1932 by 1932 pixels — 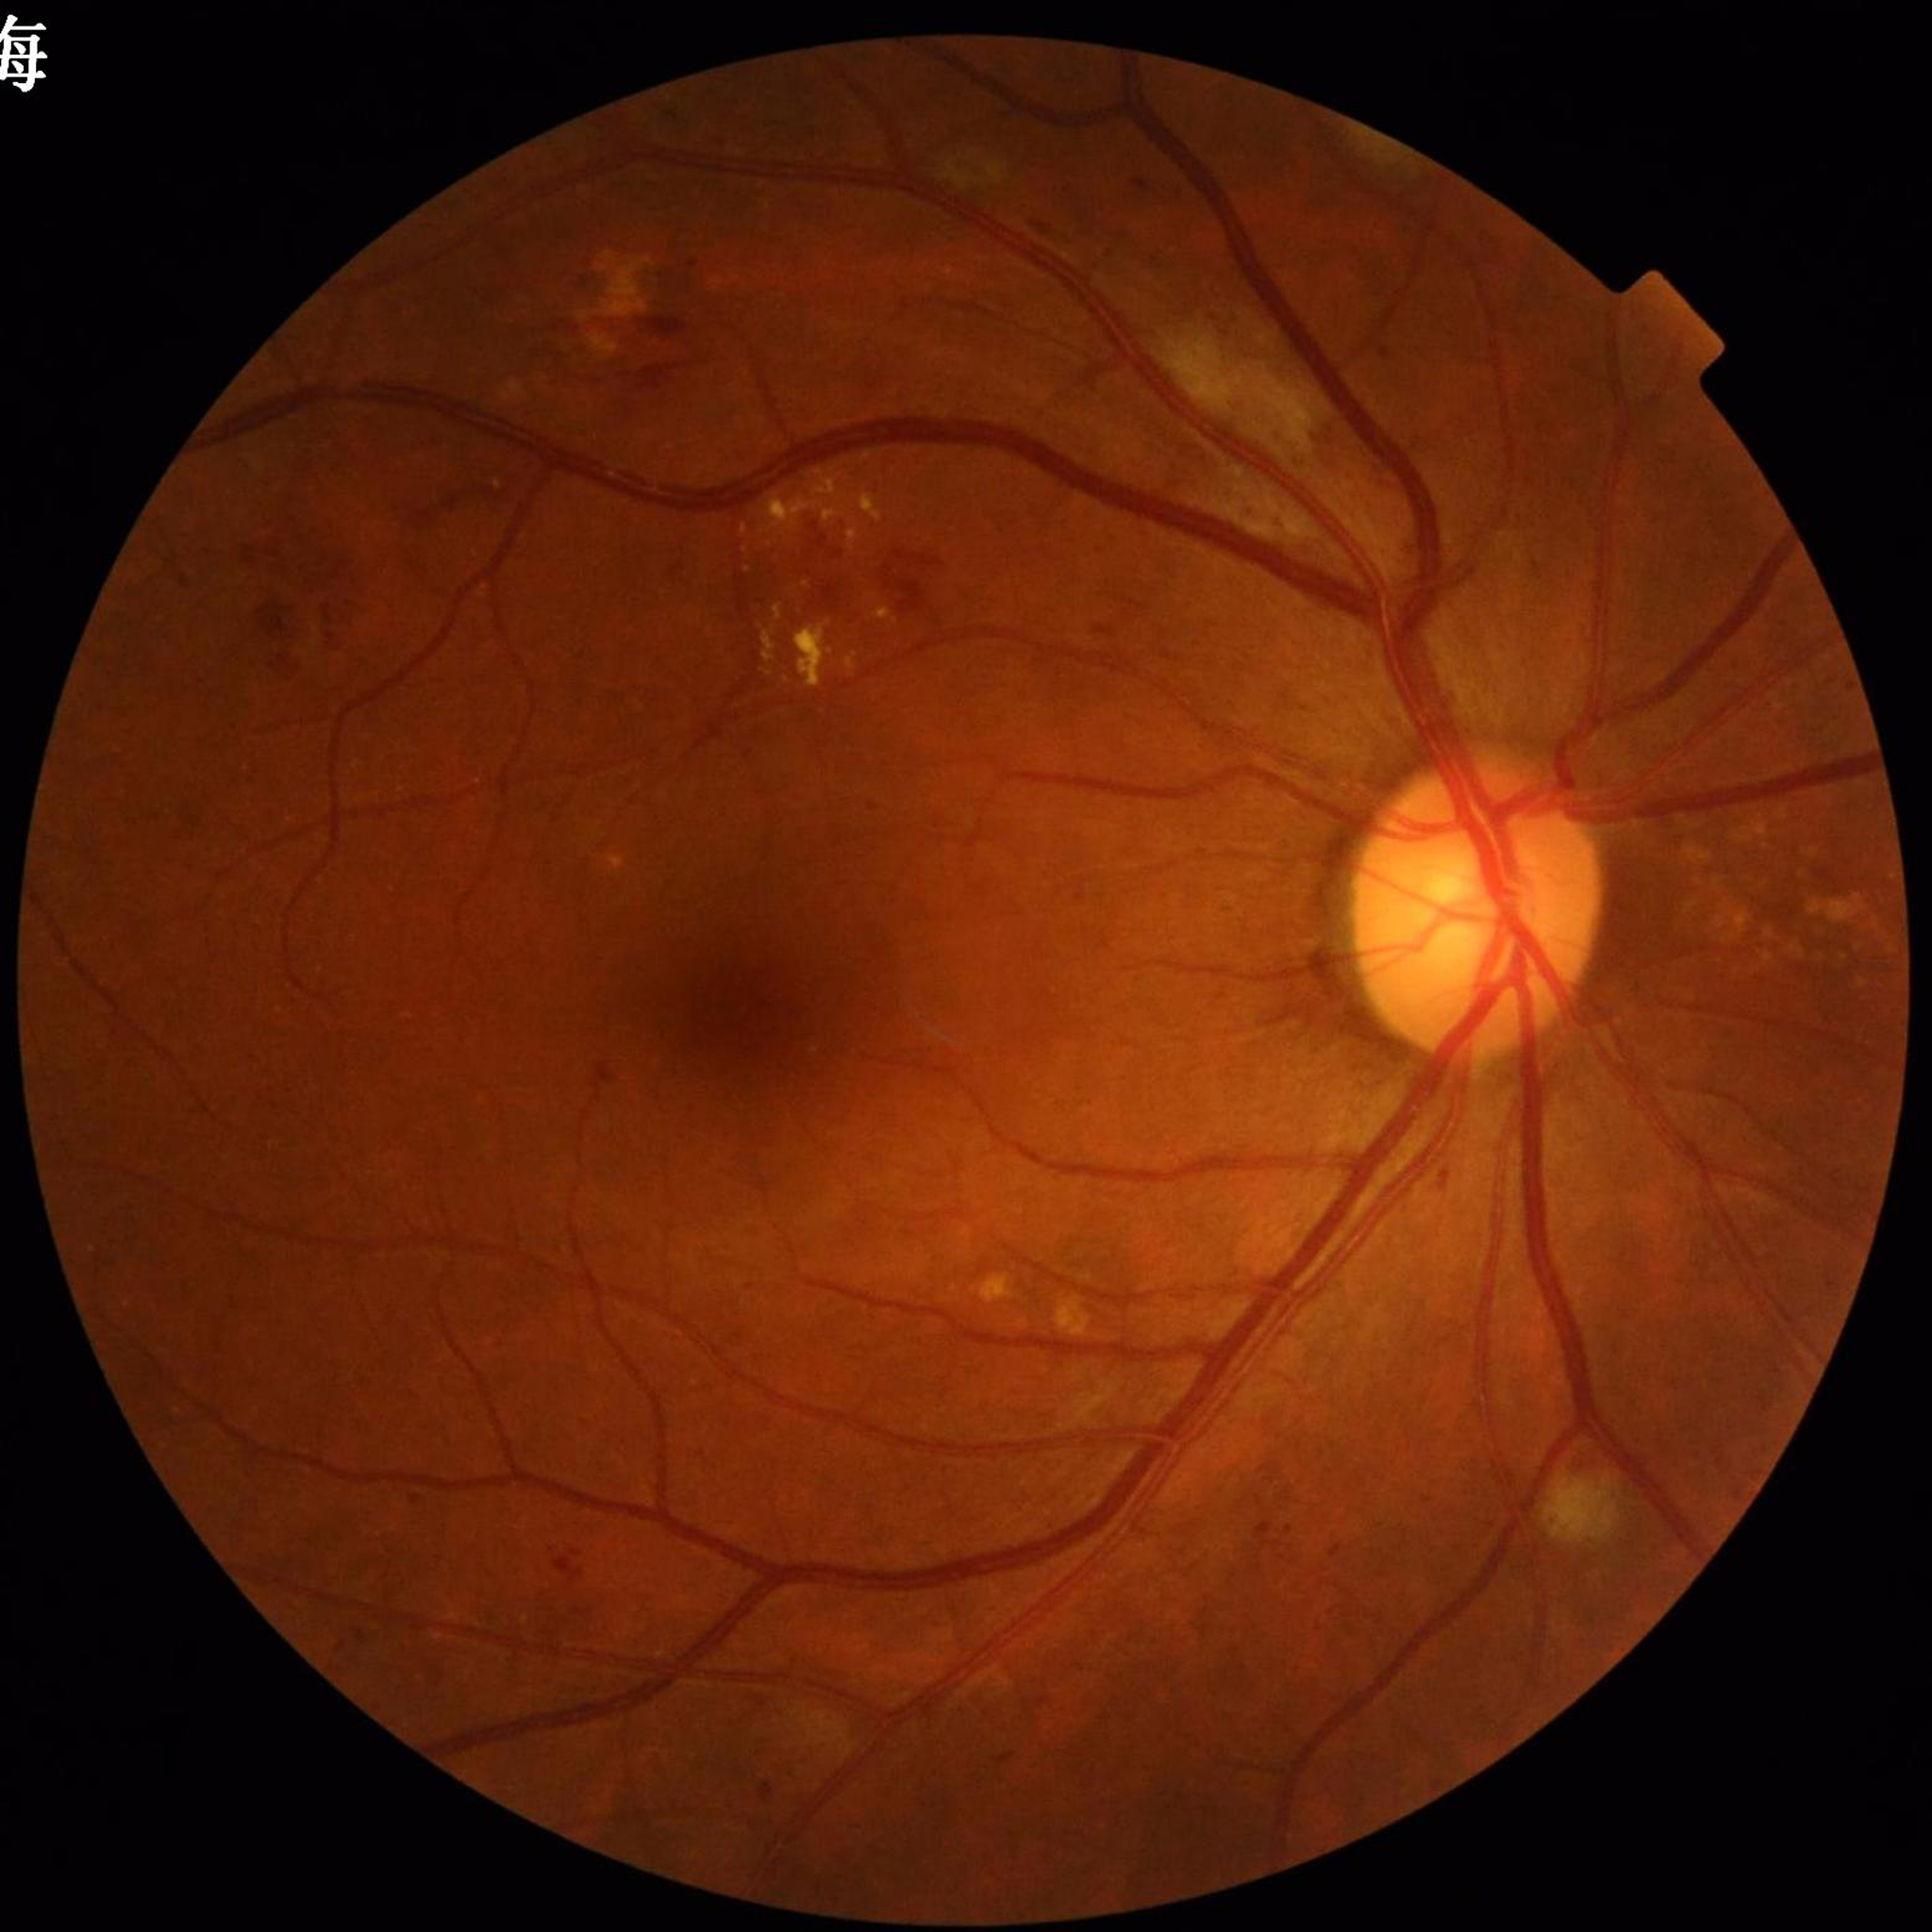
Retinal fundus photograph from a patient with diabetic retinopathy.